1932x1910px.
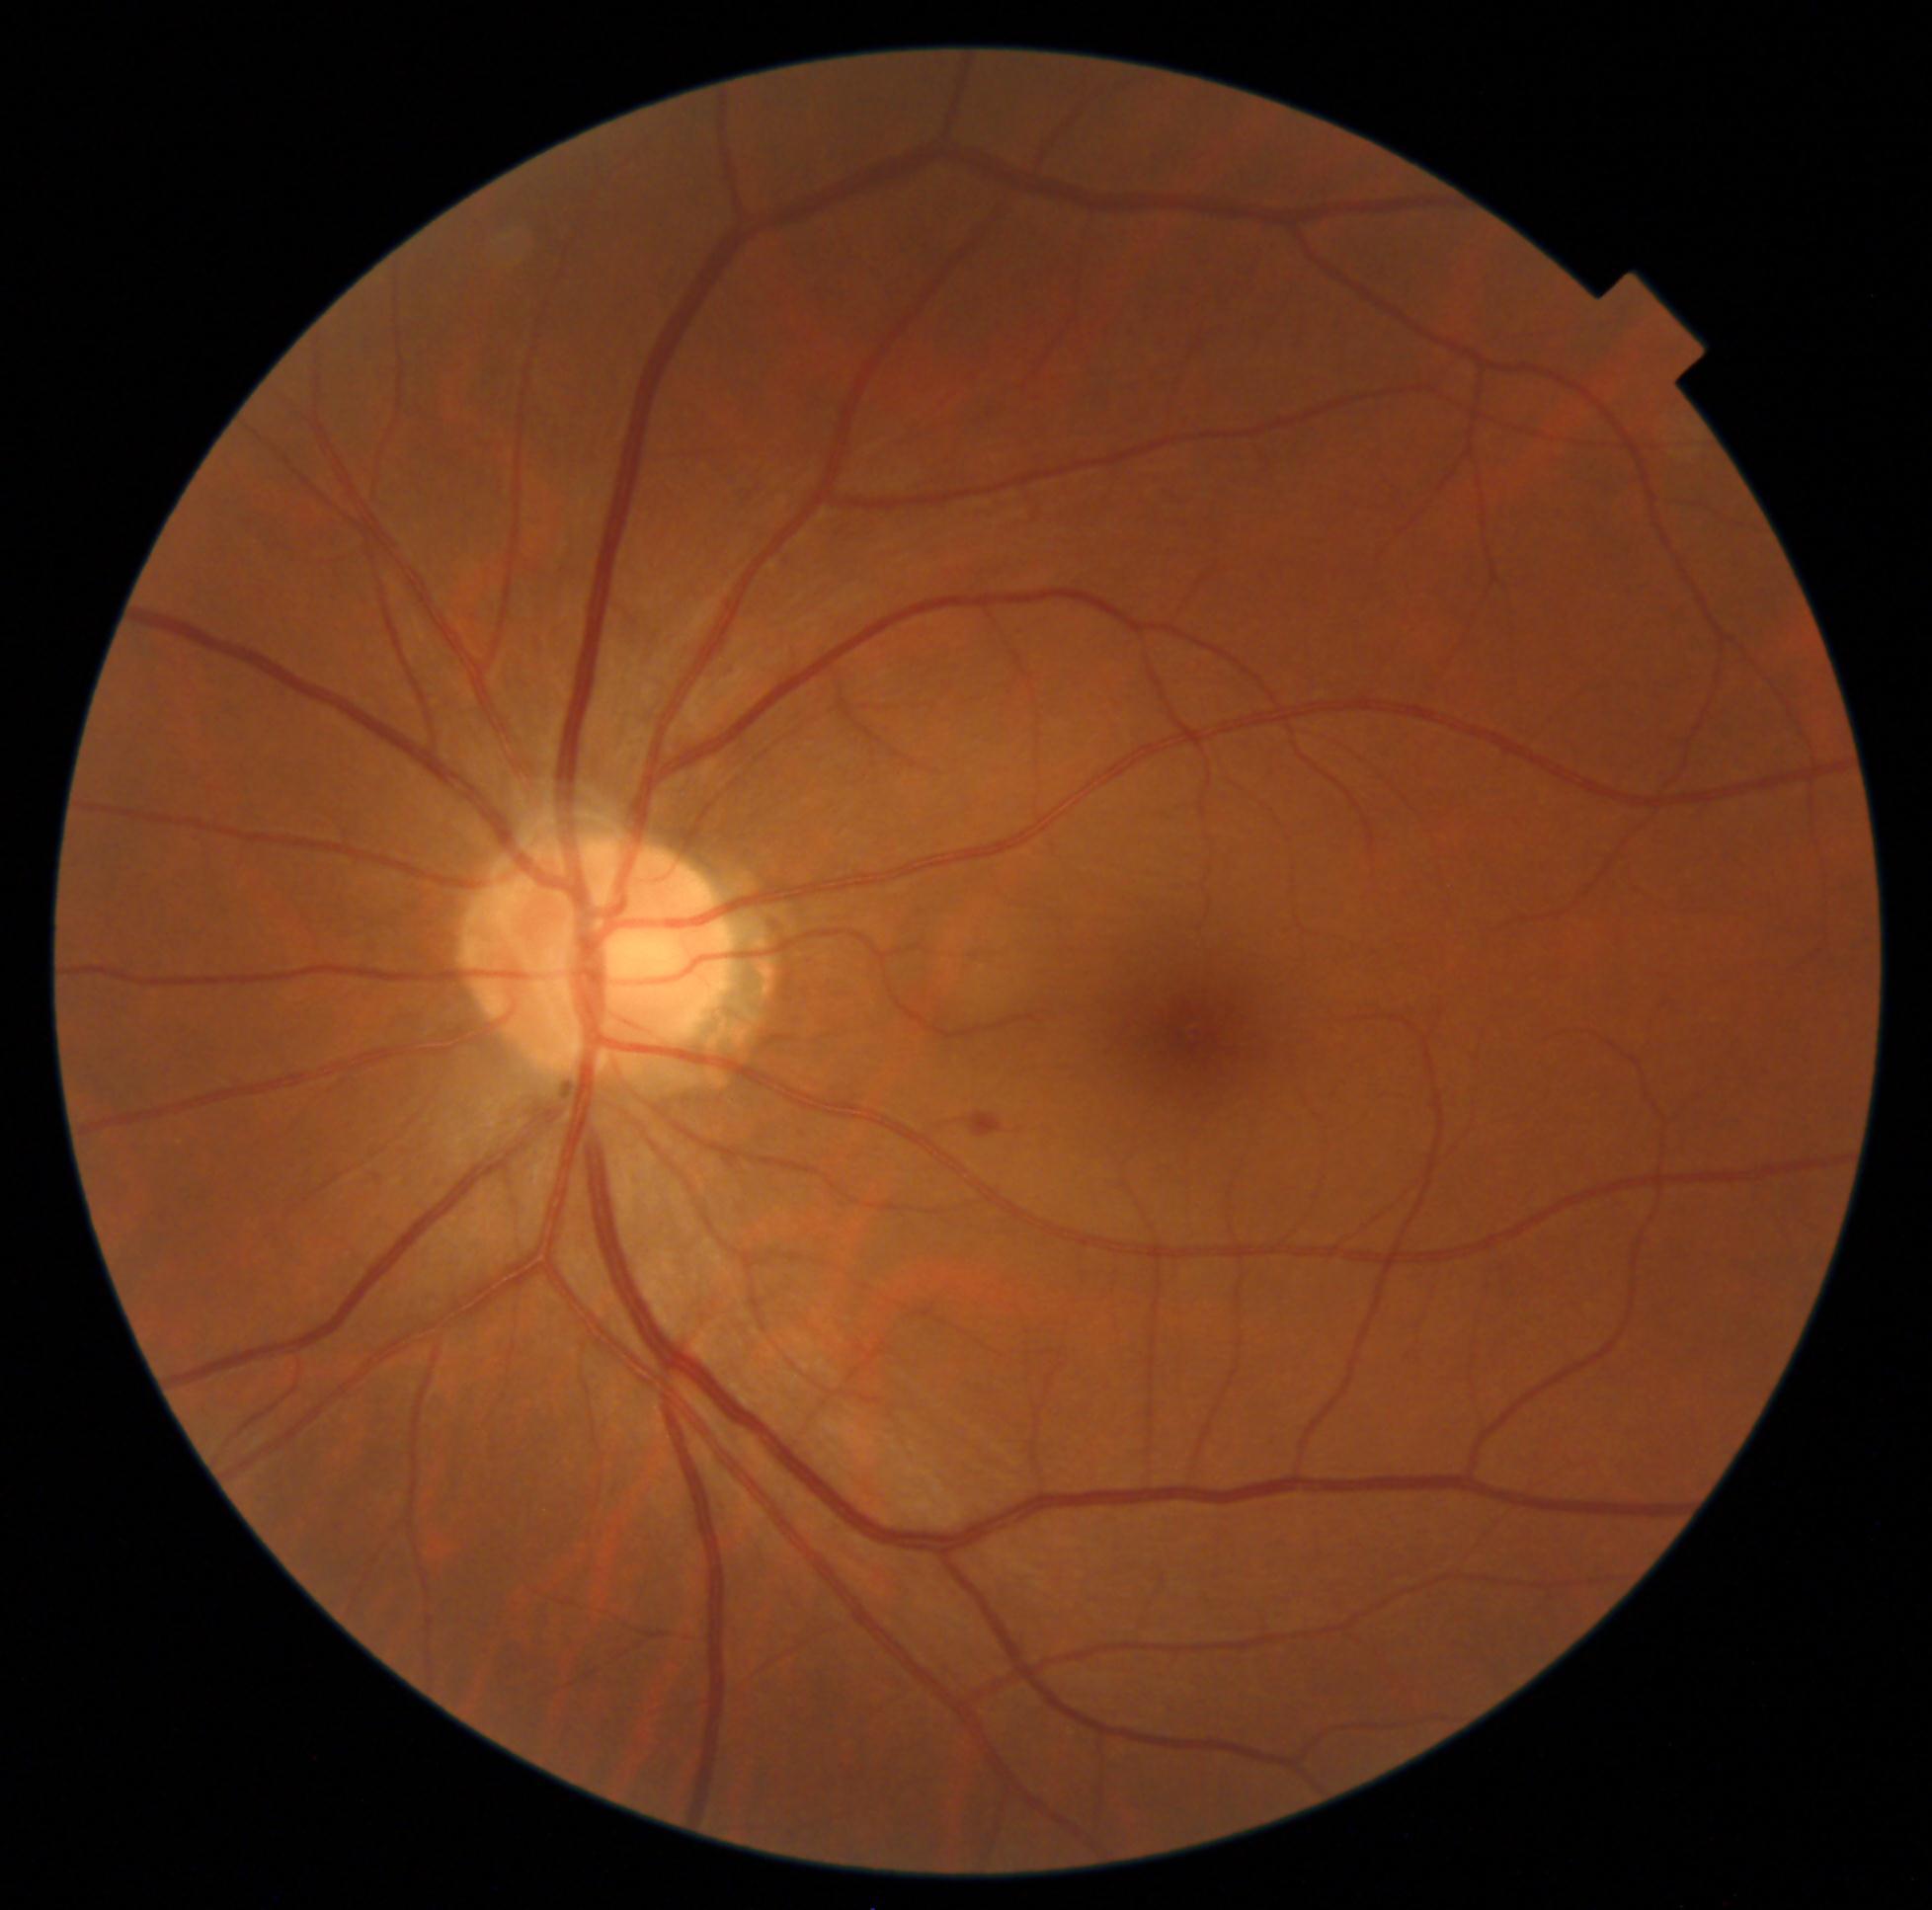 Diabetic retinopathy (DR) is grade 2 (moderate NPDR).